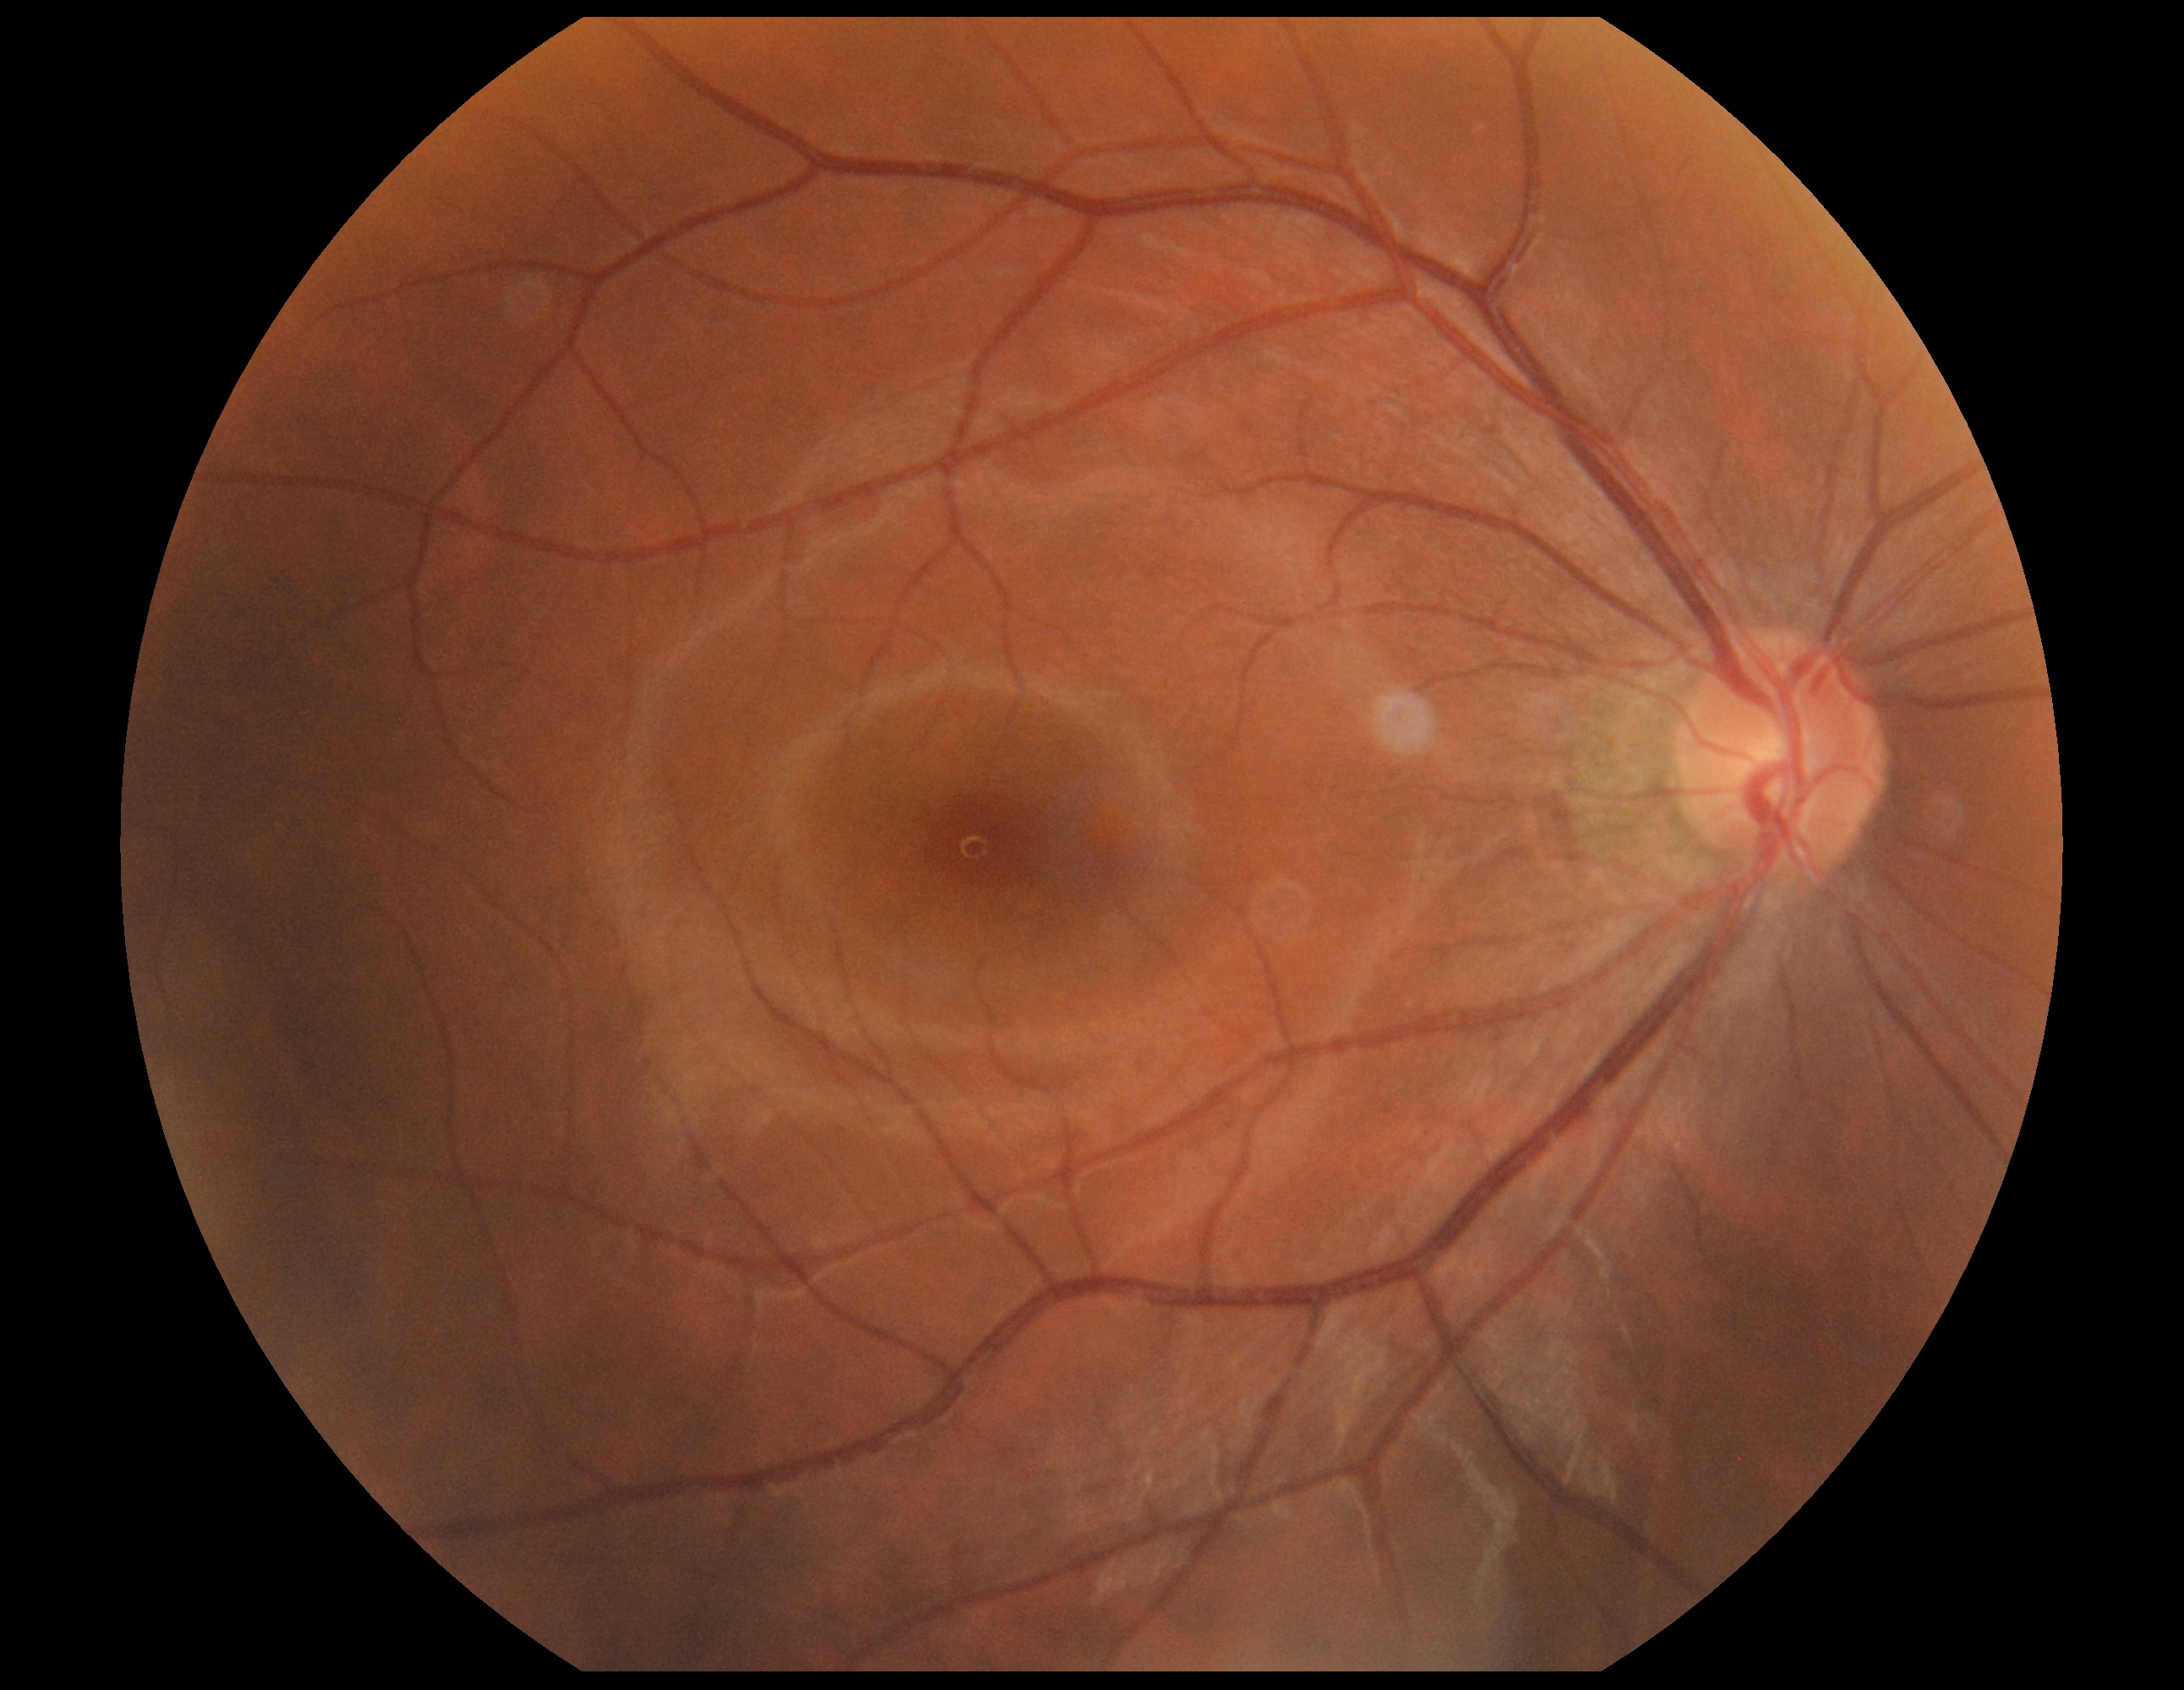

{"dr_grade": "grade 0"}